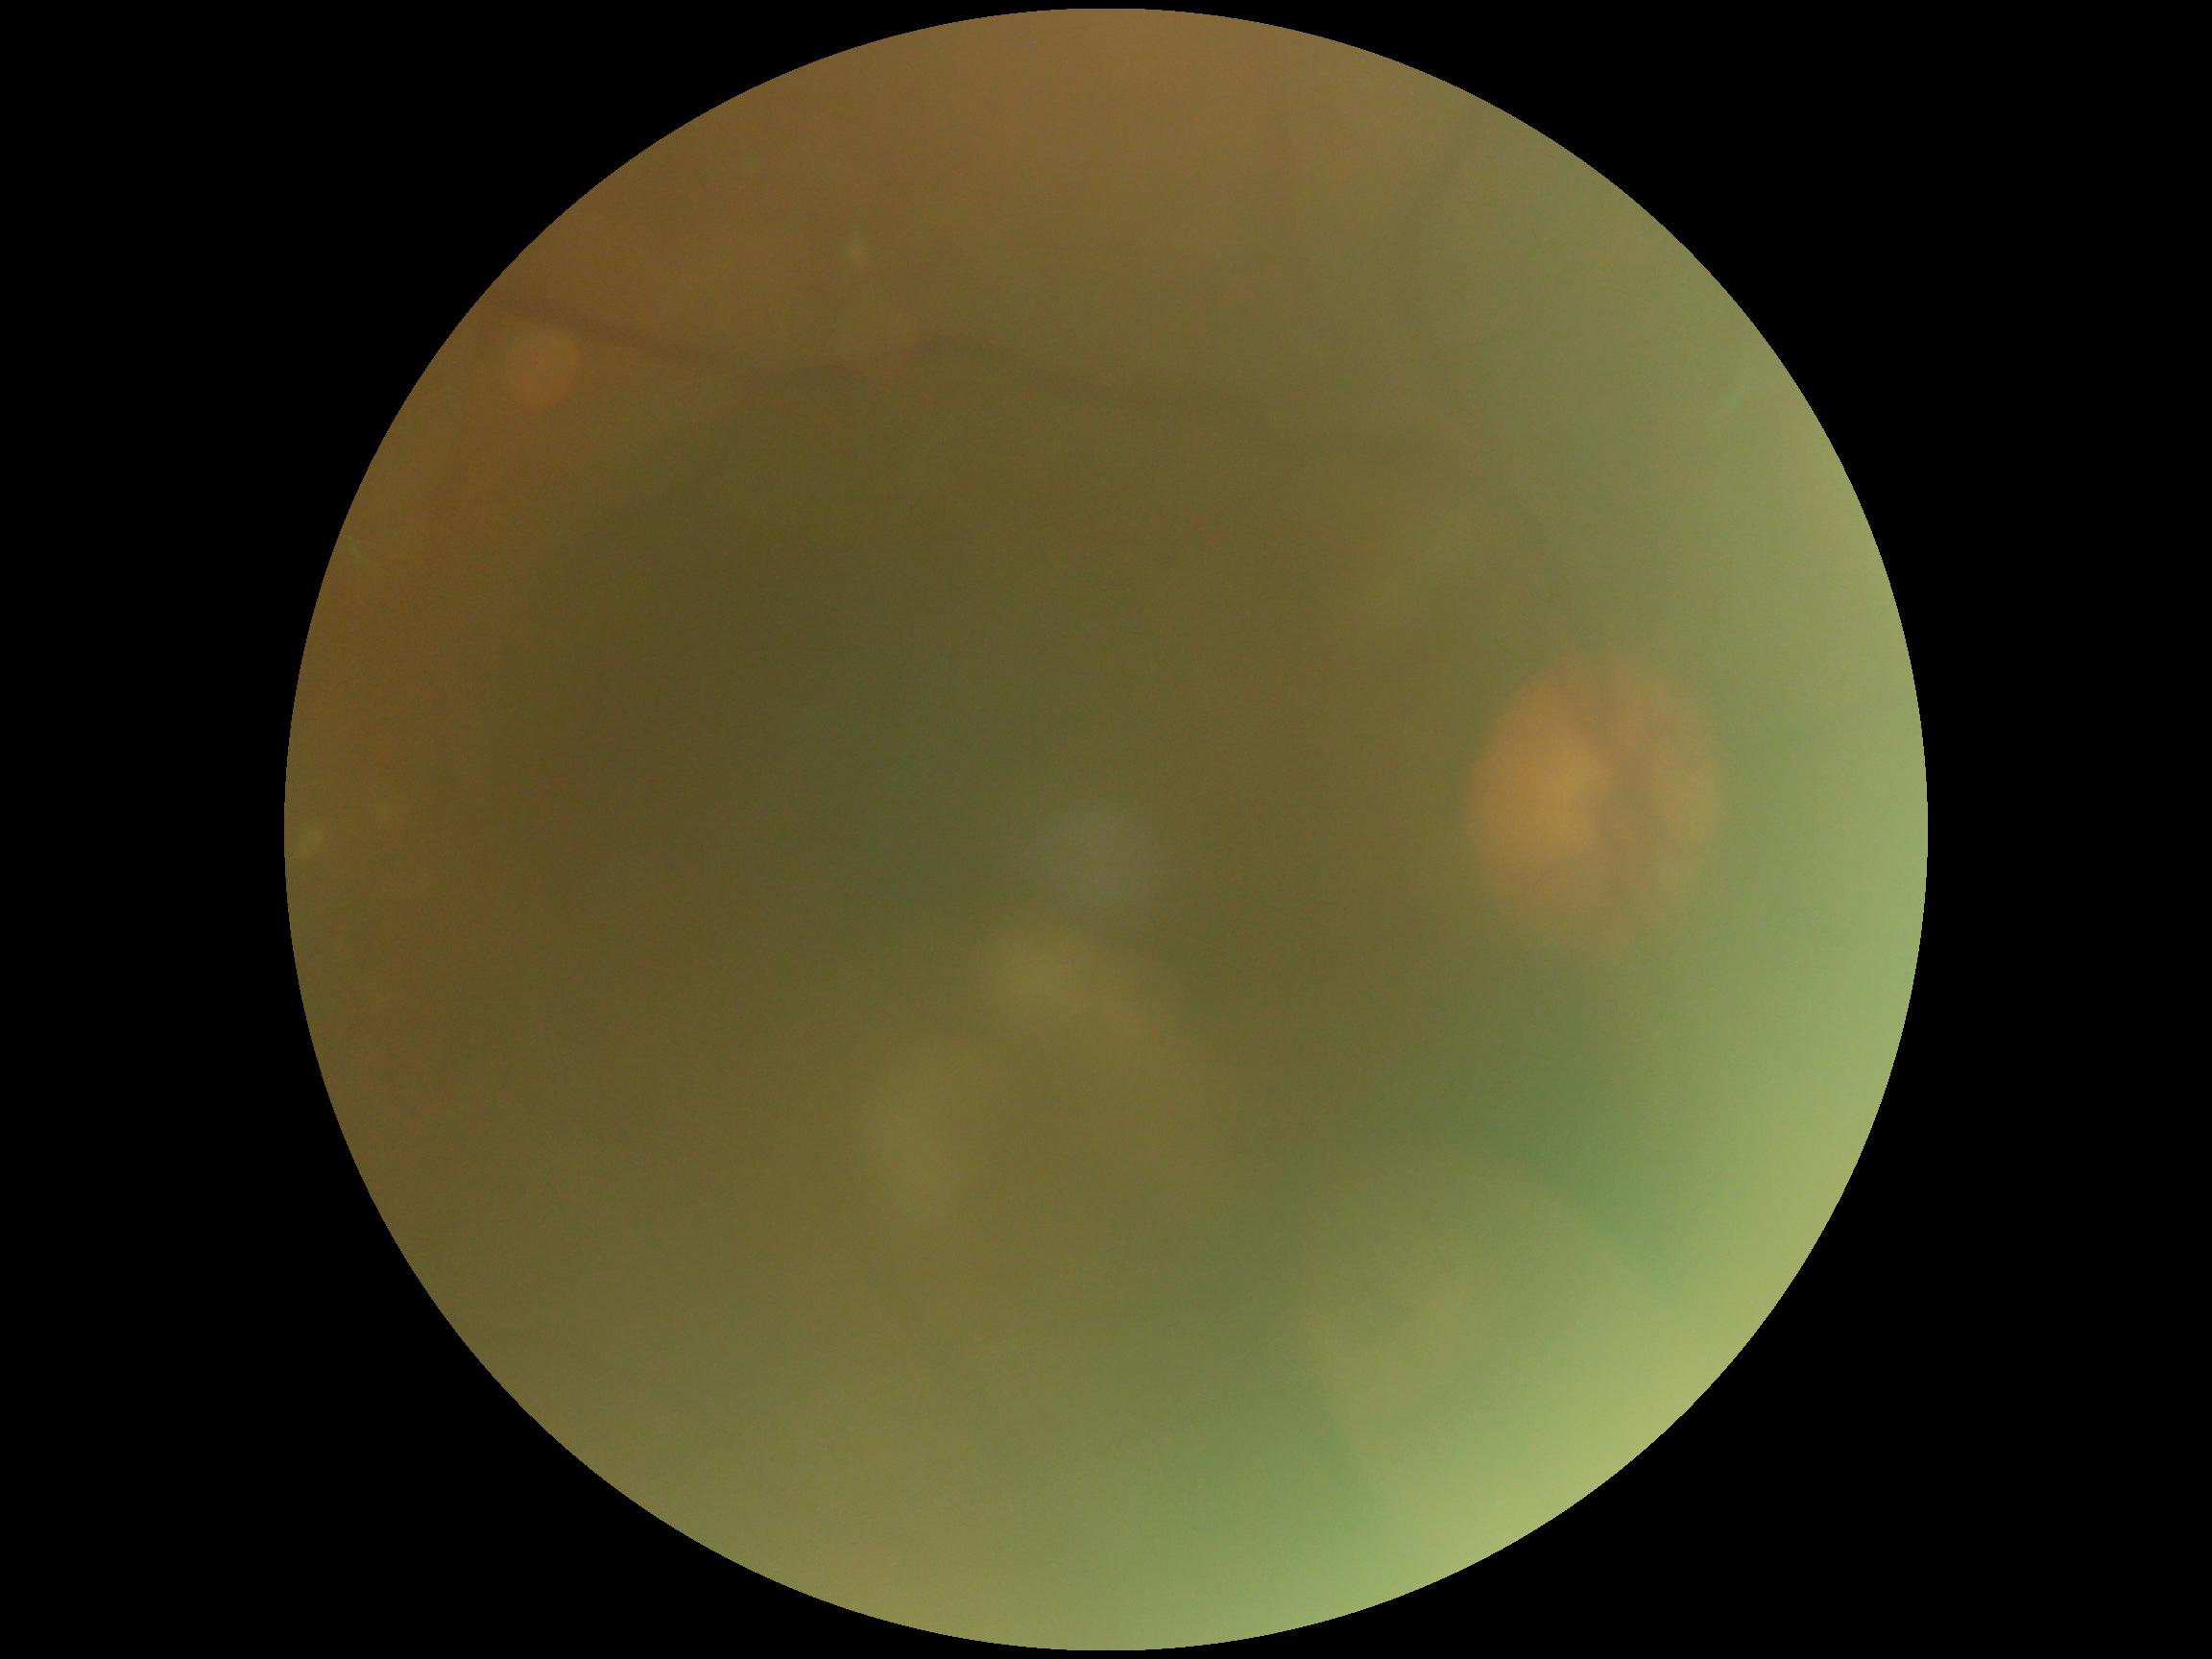
The image cannot be graded for diabetic retinopathy. DR stage: ungradable due to poor image quality.